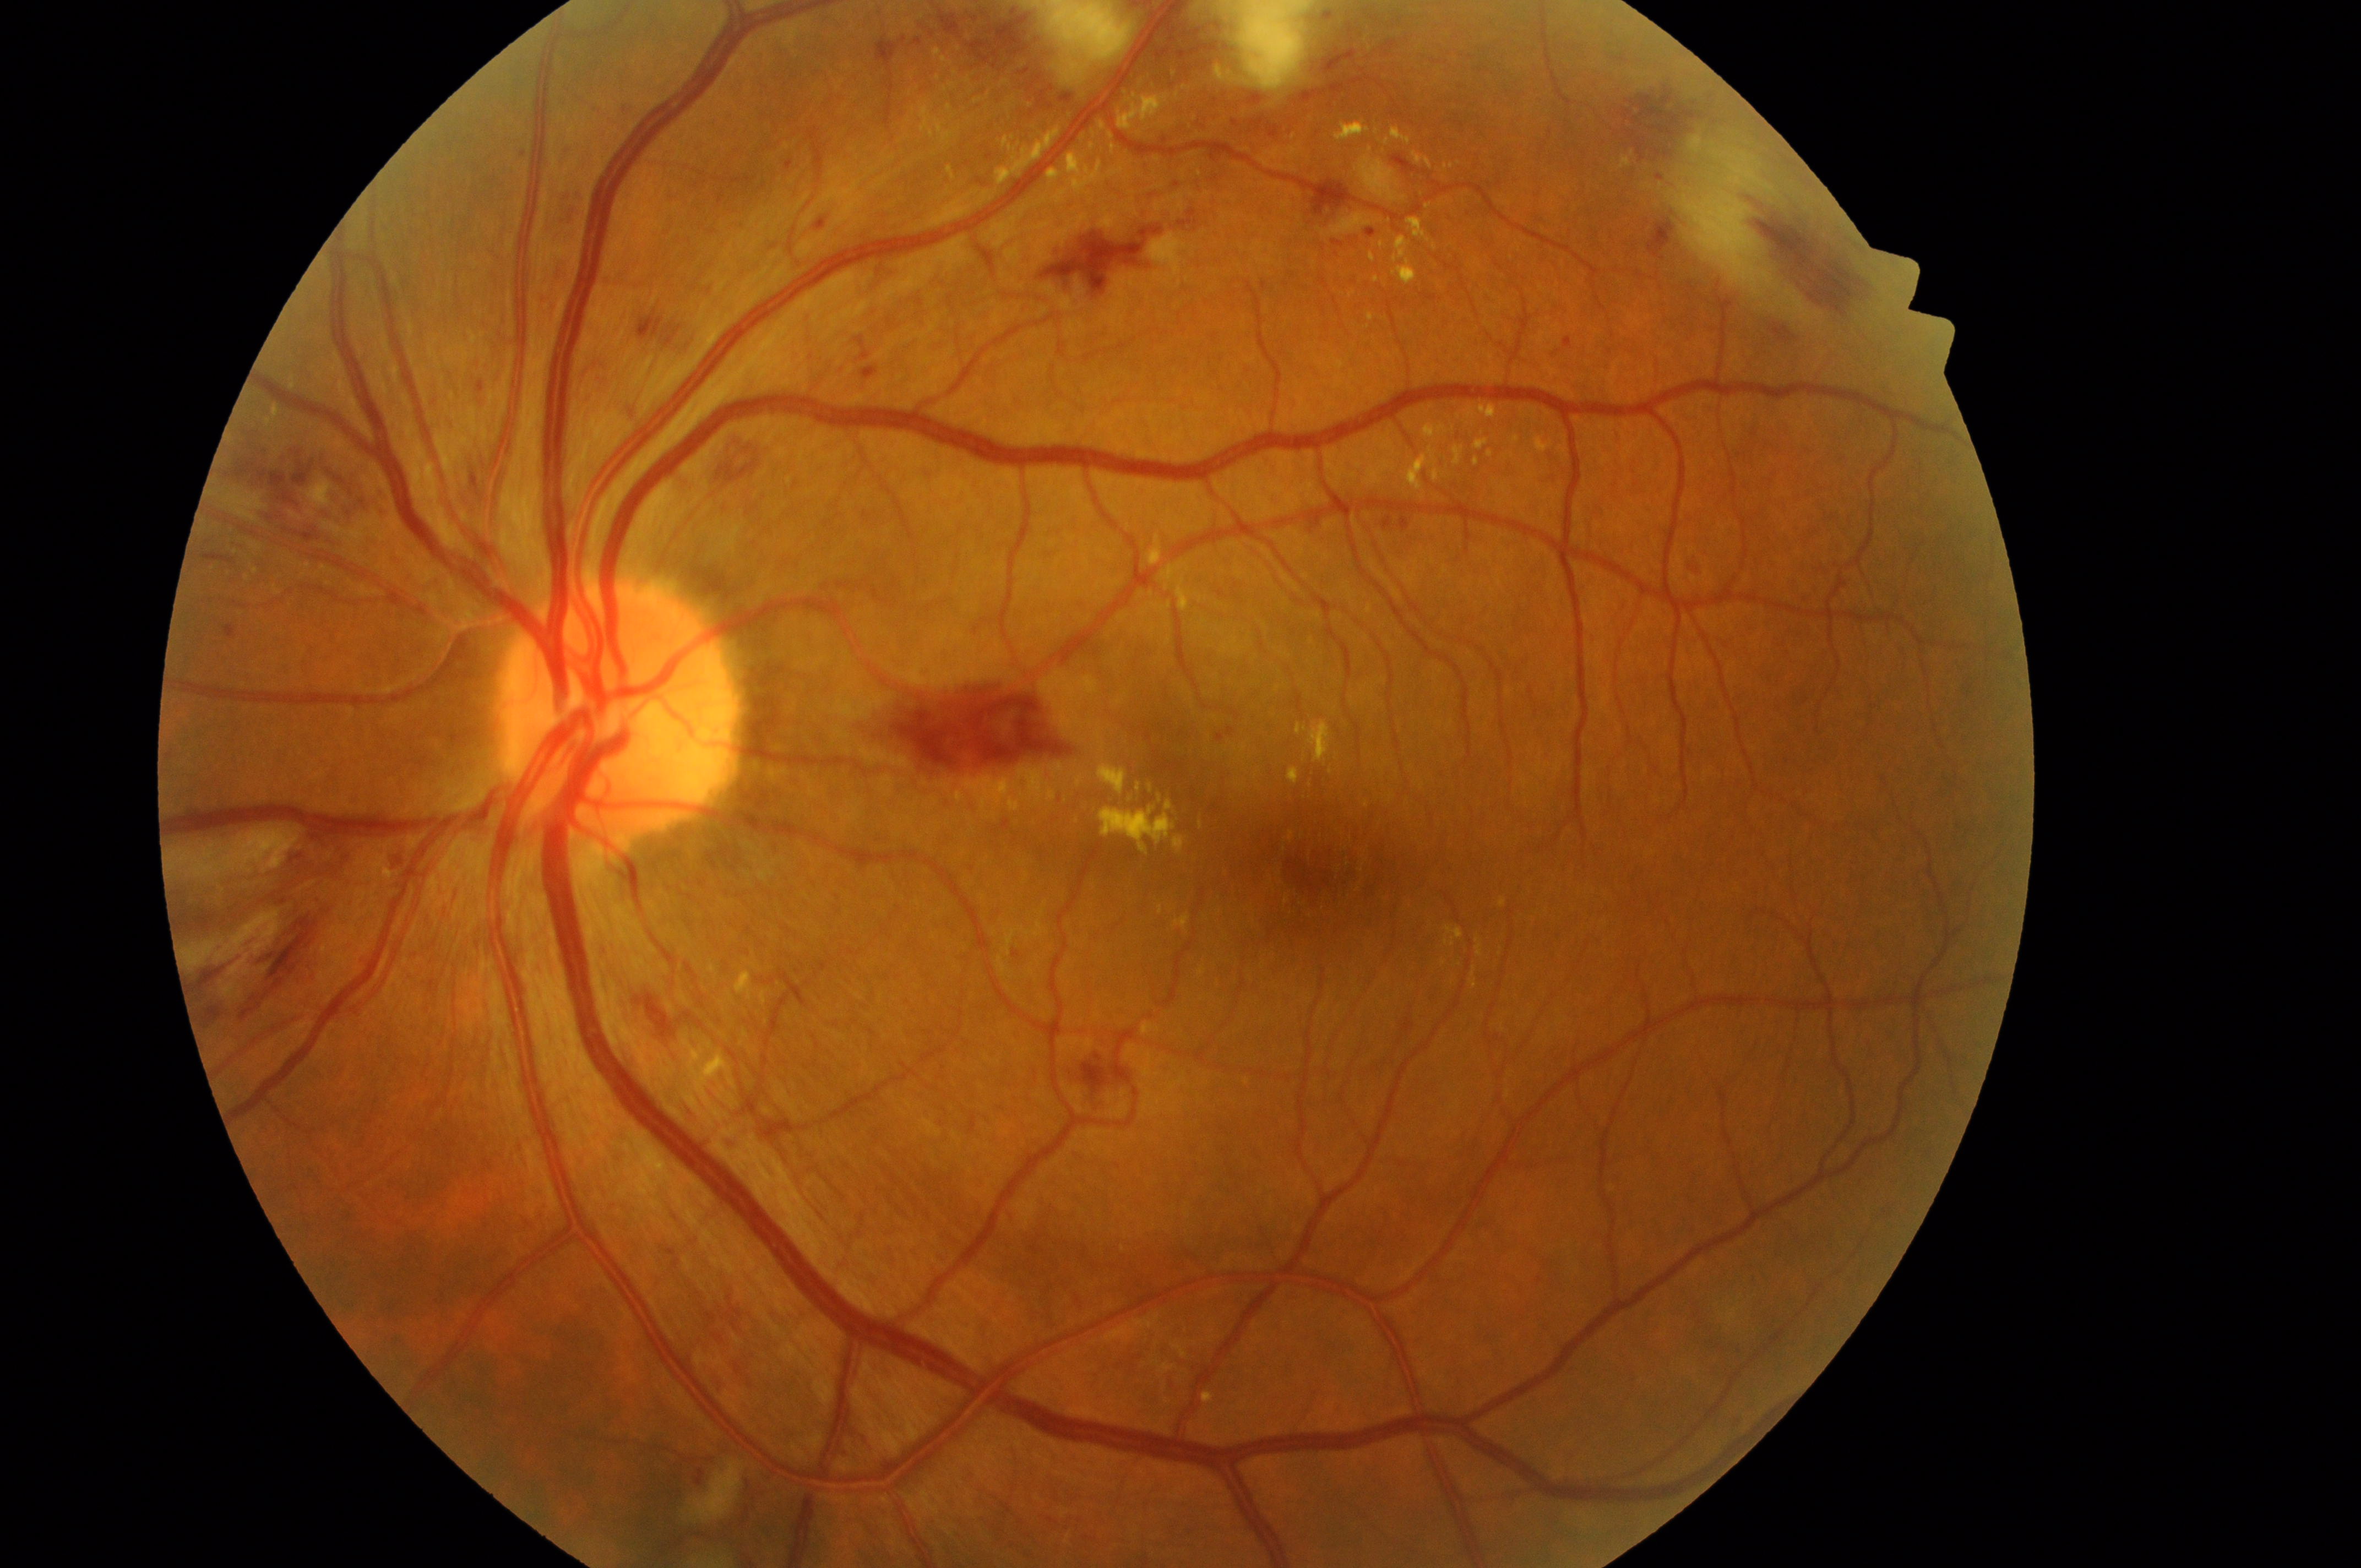
Q: What is the laterality?
A: OS
Q: Optic disc center?
A: [617, 717]
Q: What is the DR grade?
A: 2 — more than just microaneurysms but less than severe NPDR
Q: Fovea center?
A: [1332, 870]
Q: What is the DME risk grade?
A: 2 — hard exudates within one disc diameter of the macula center